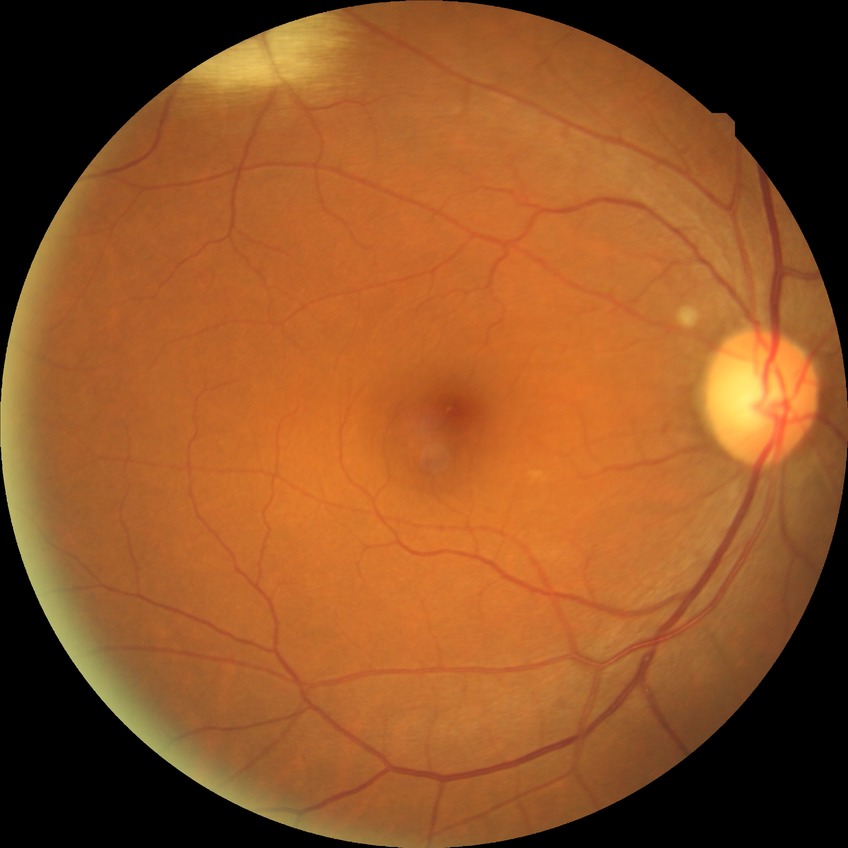
  davis_grade: no diabetic retinopathy